Retinal fundus photograph.
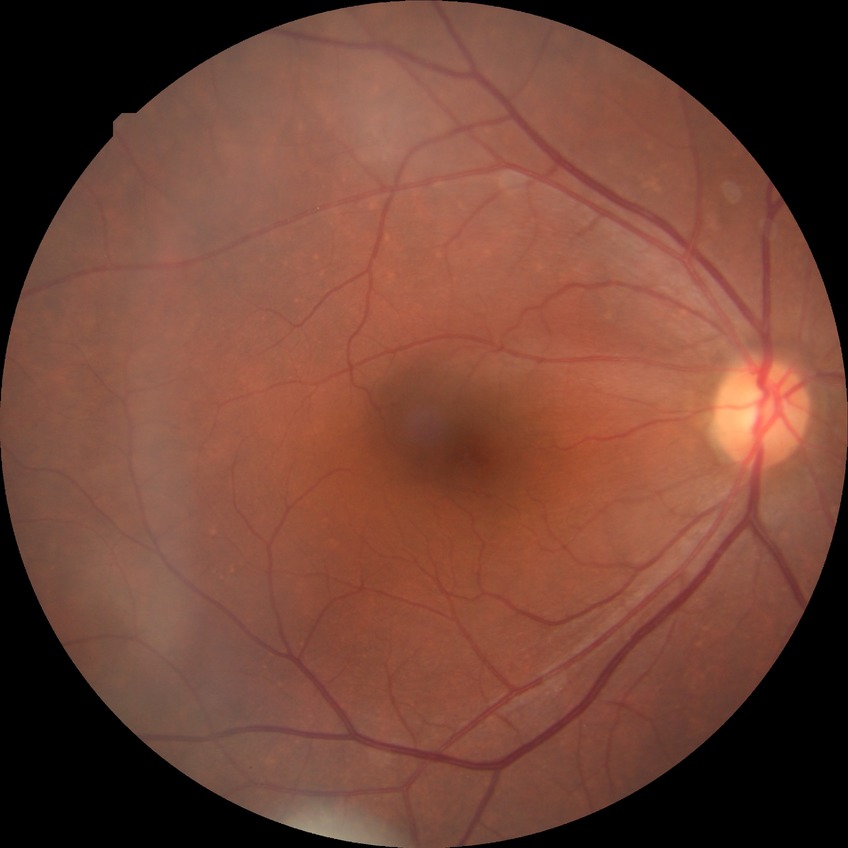

{
  "davis_grade": "NDR (no diabetic retinopathy)"
}